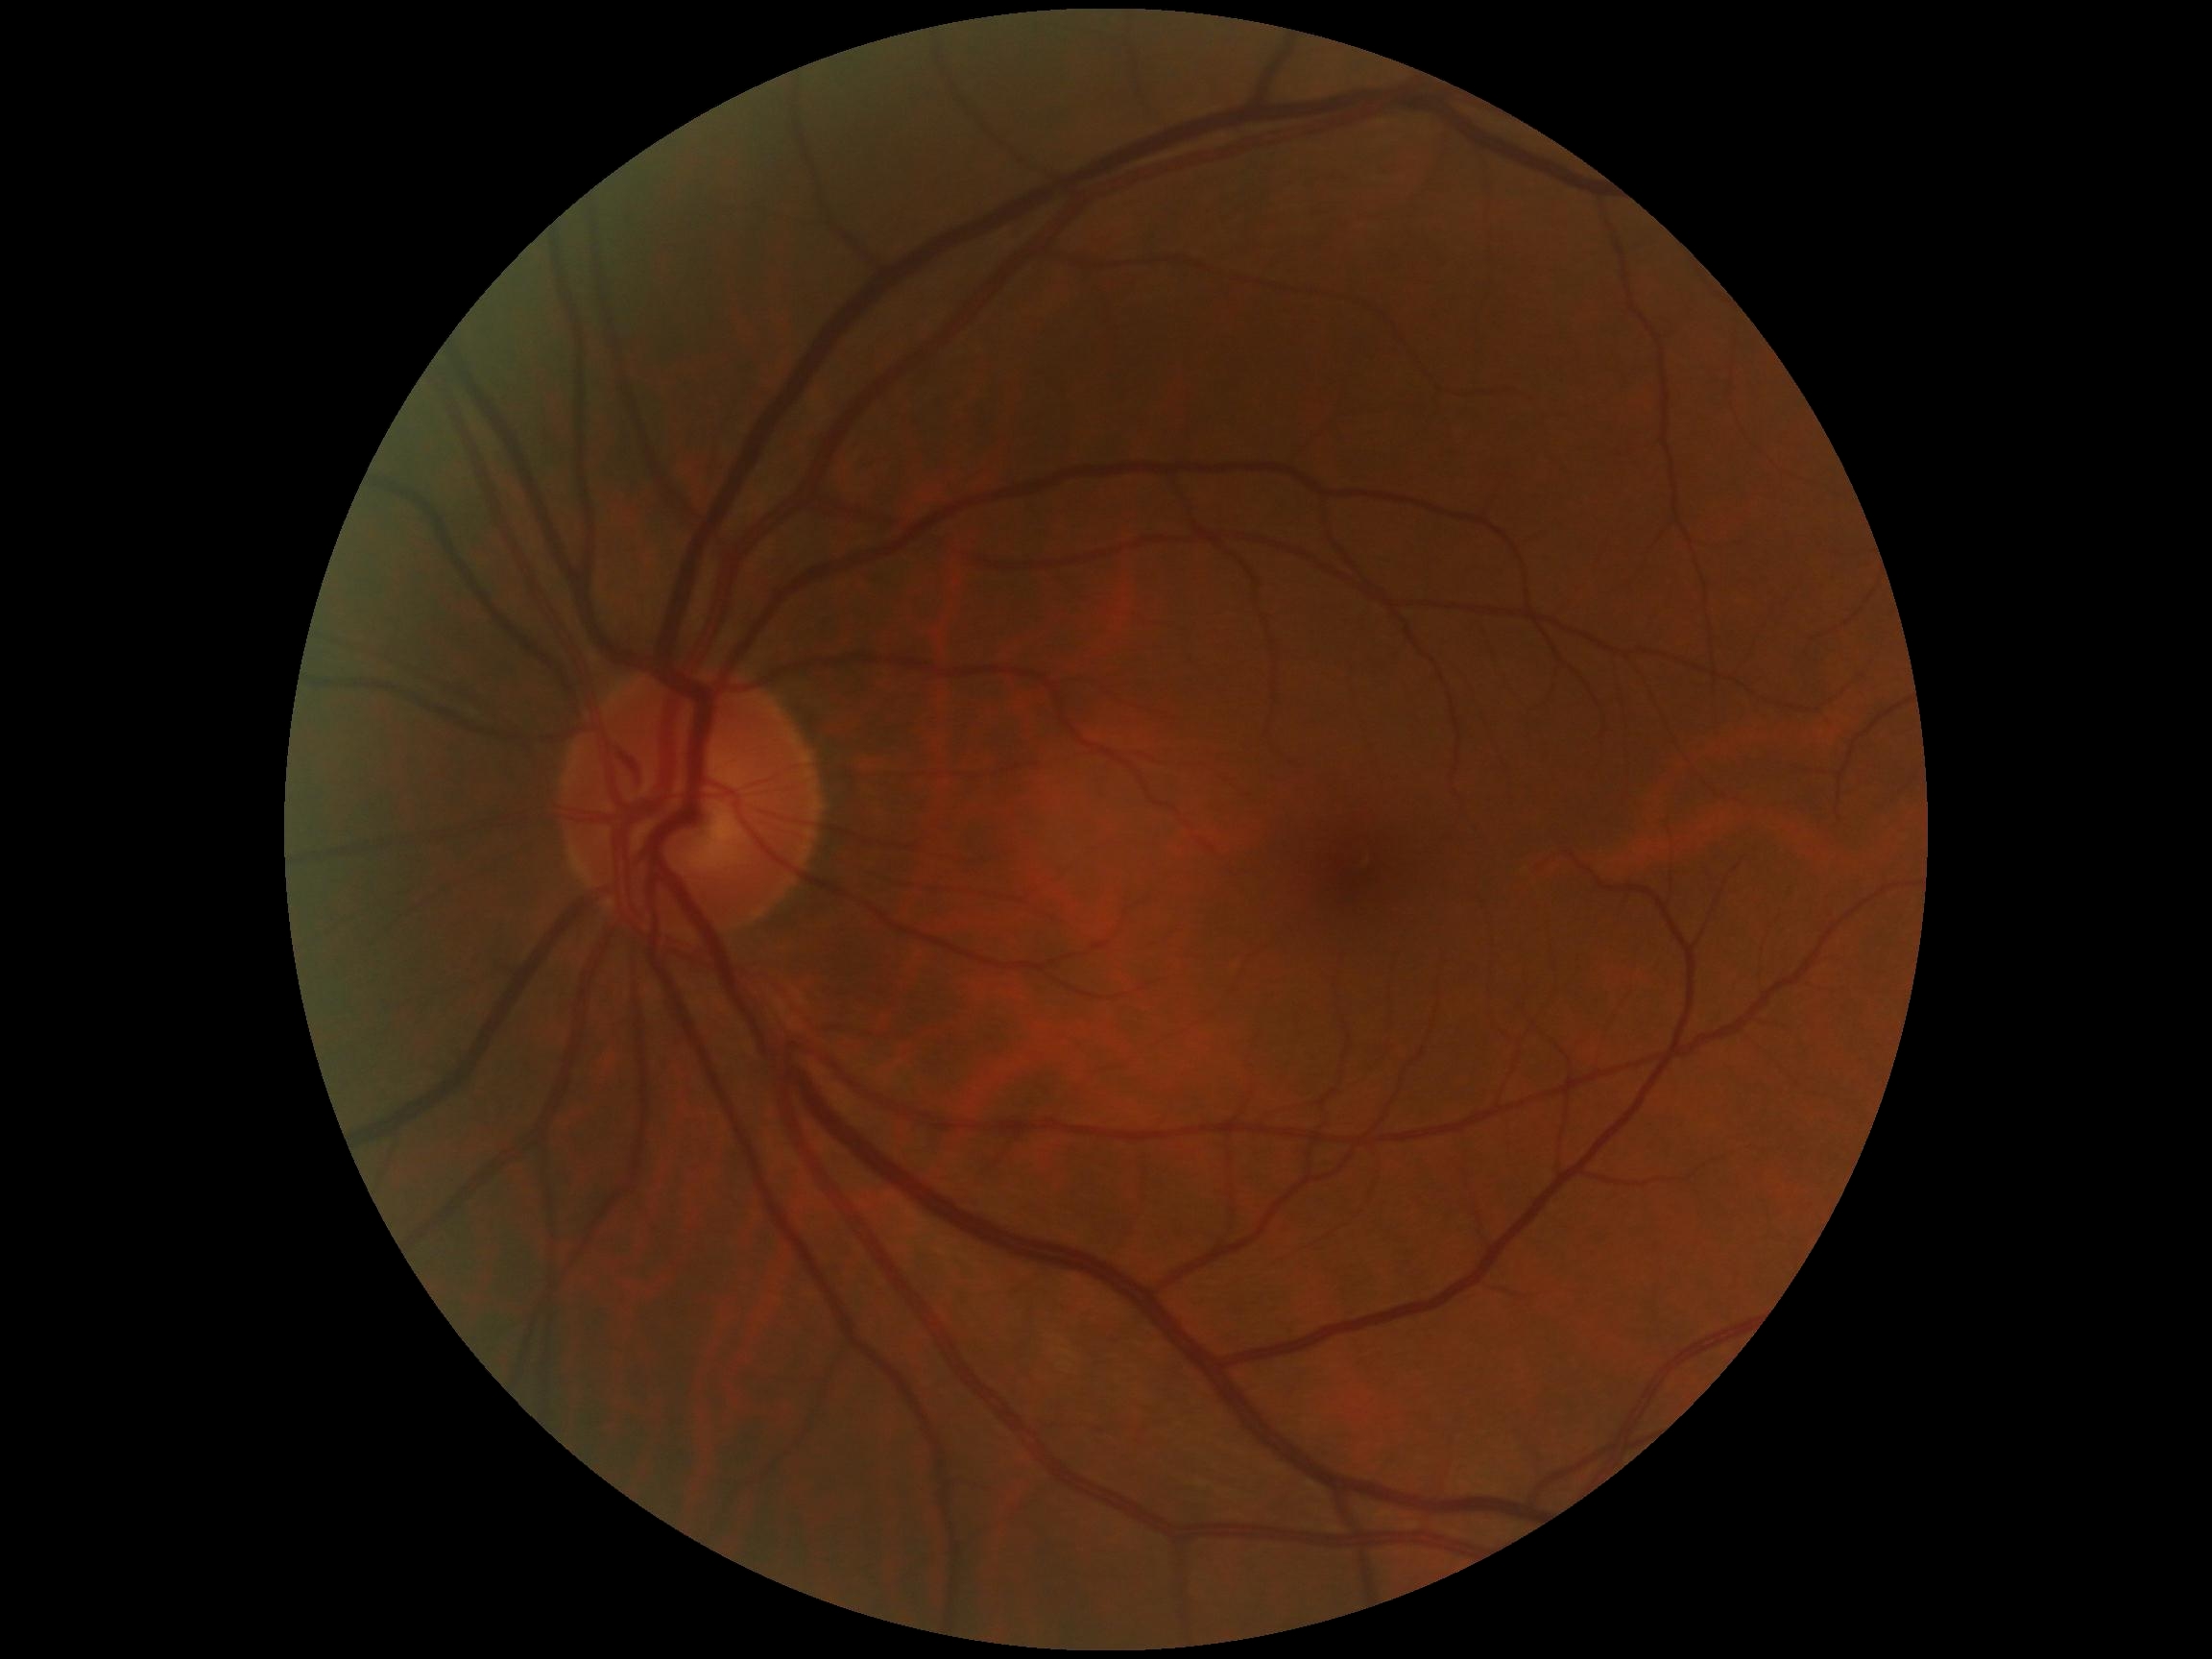
Diabetic retinopathy grade is 0/4.